45° field of view:
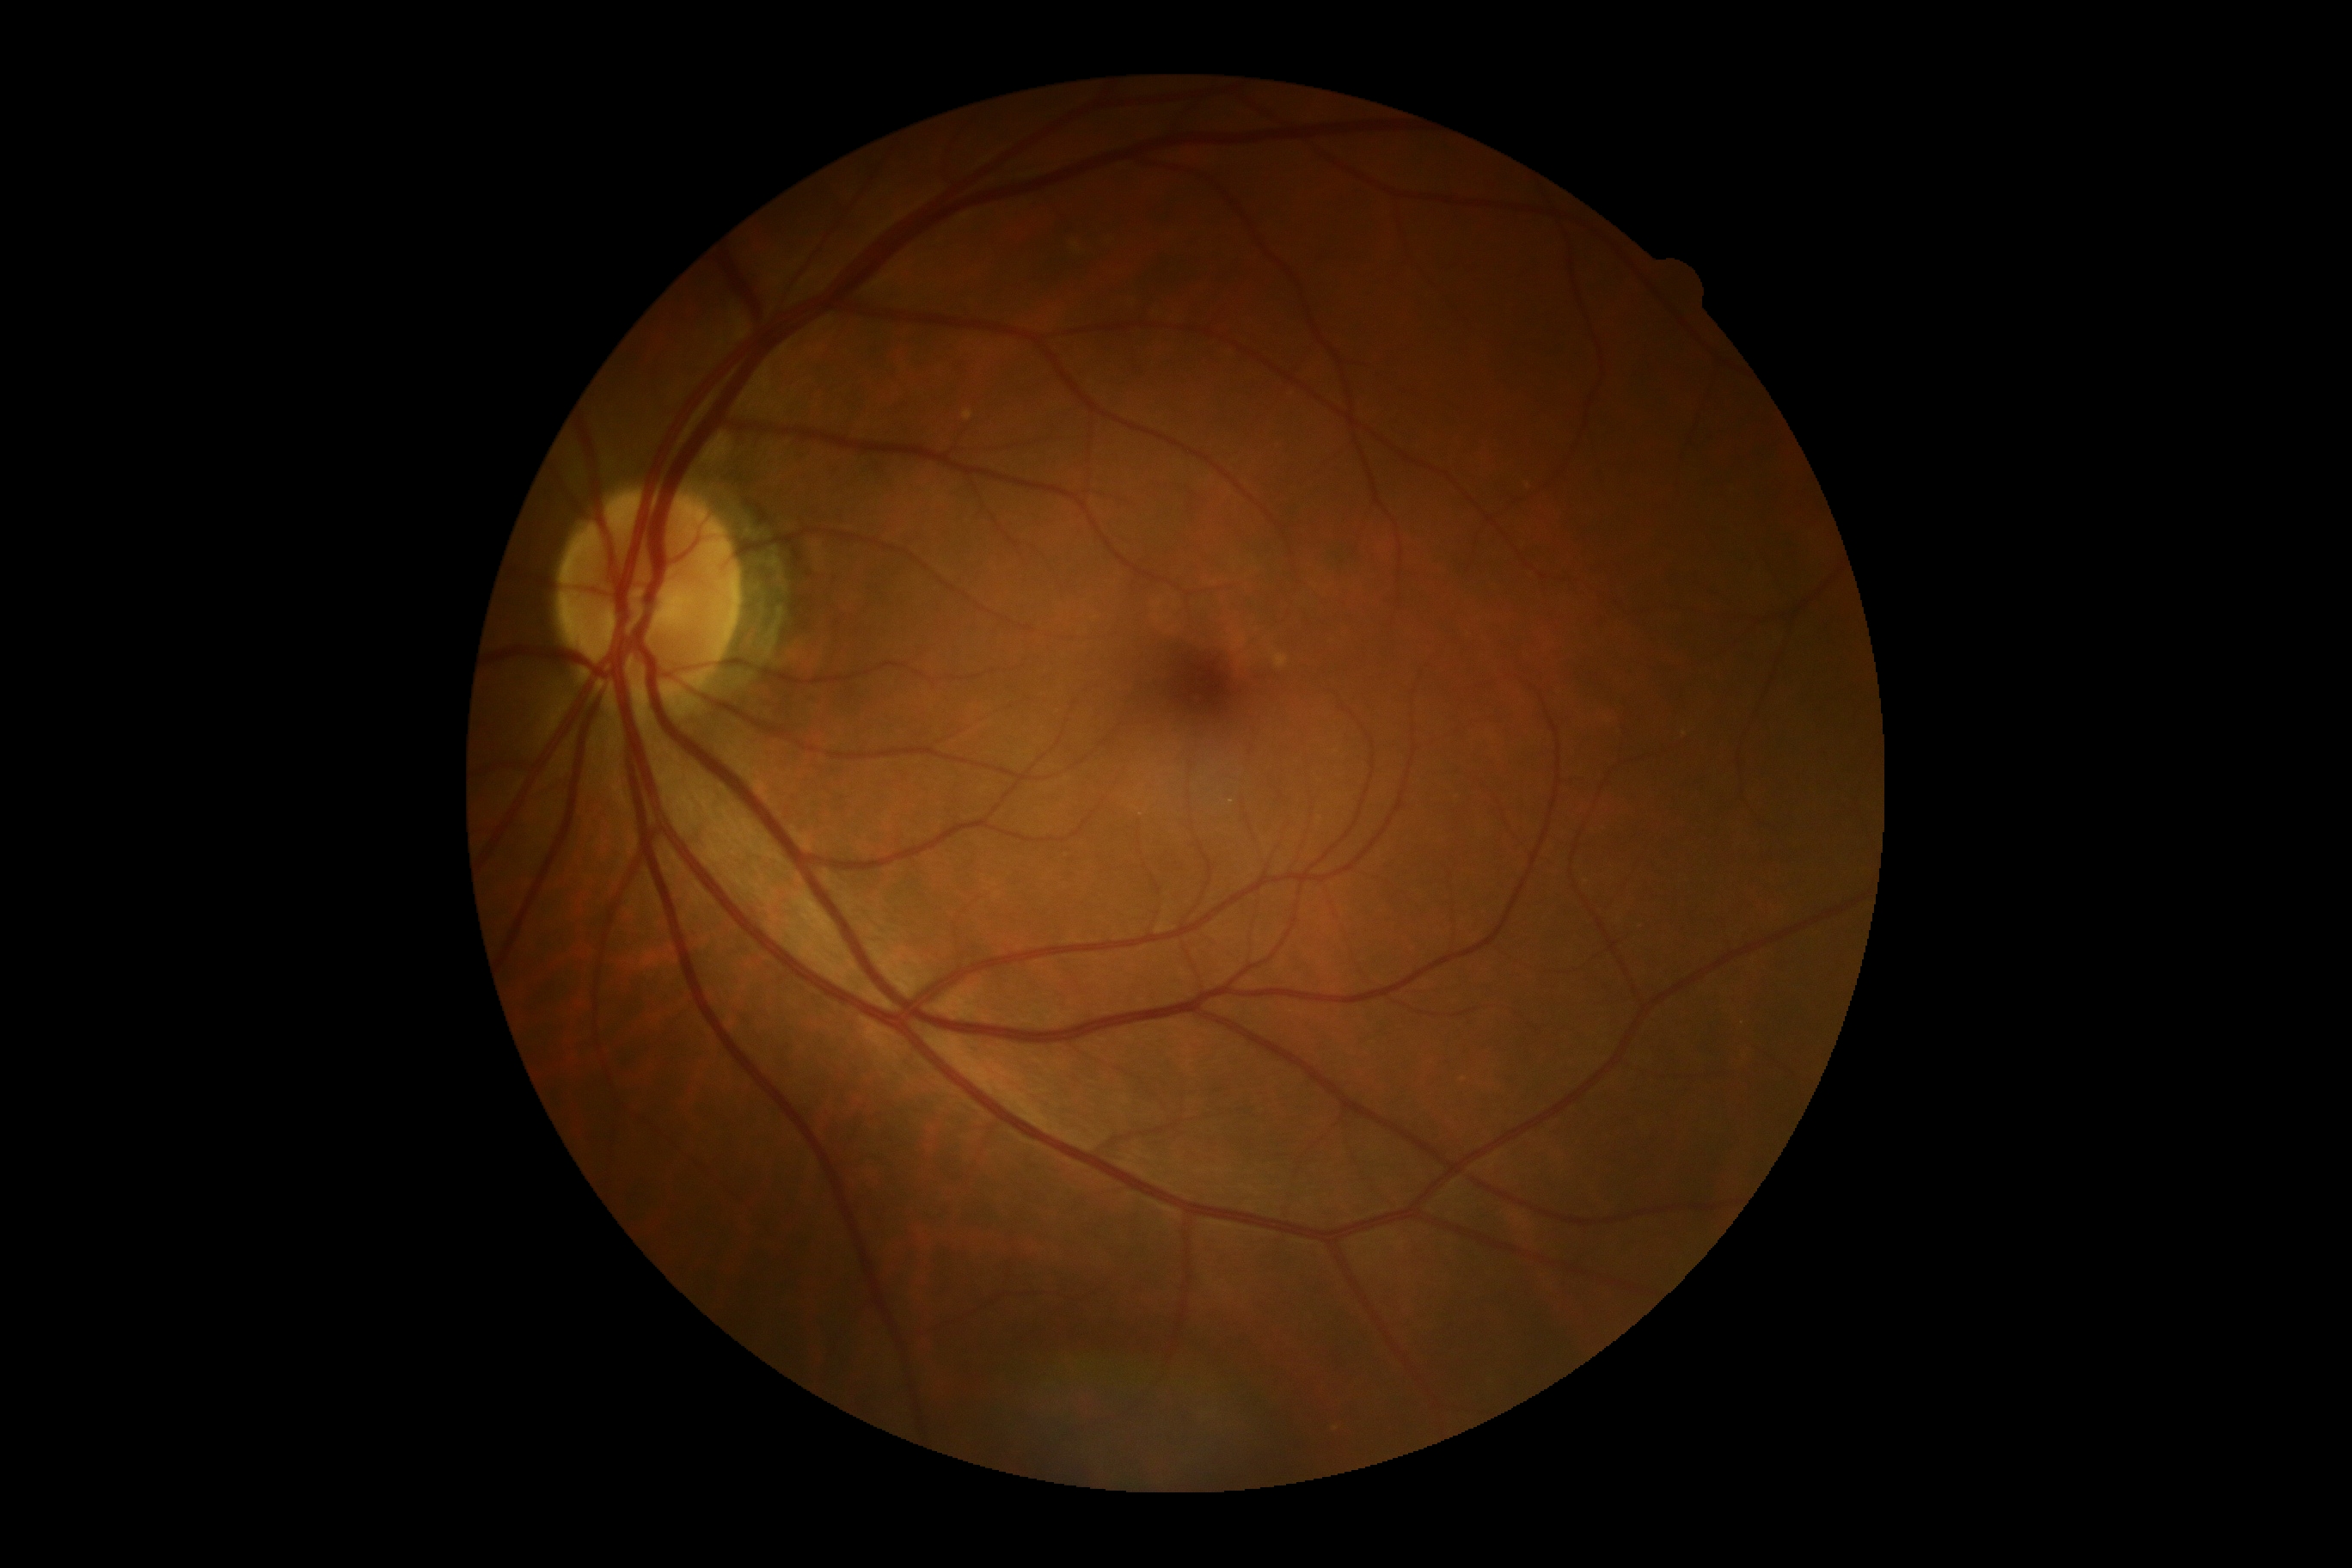

dr_grade: 0